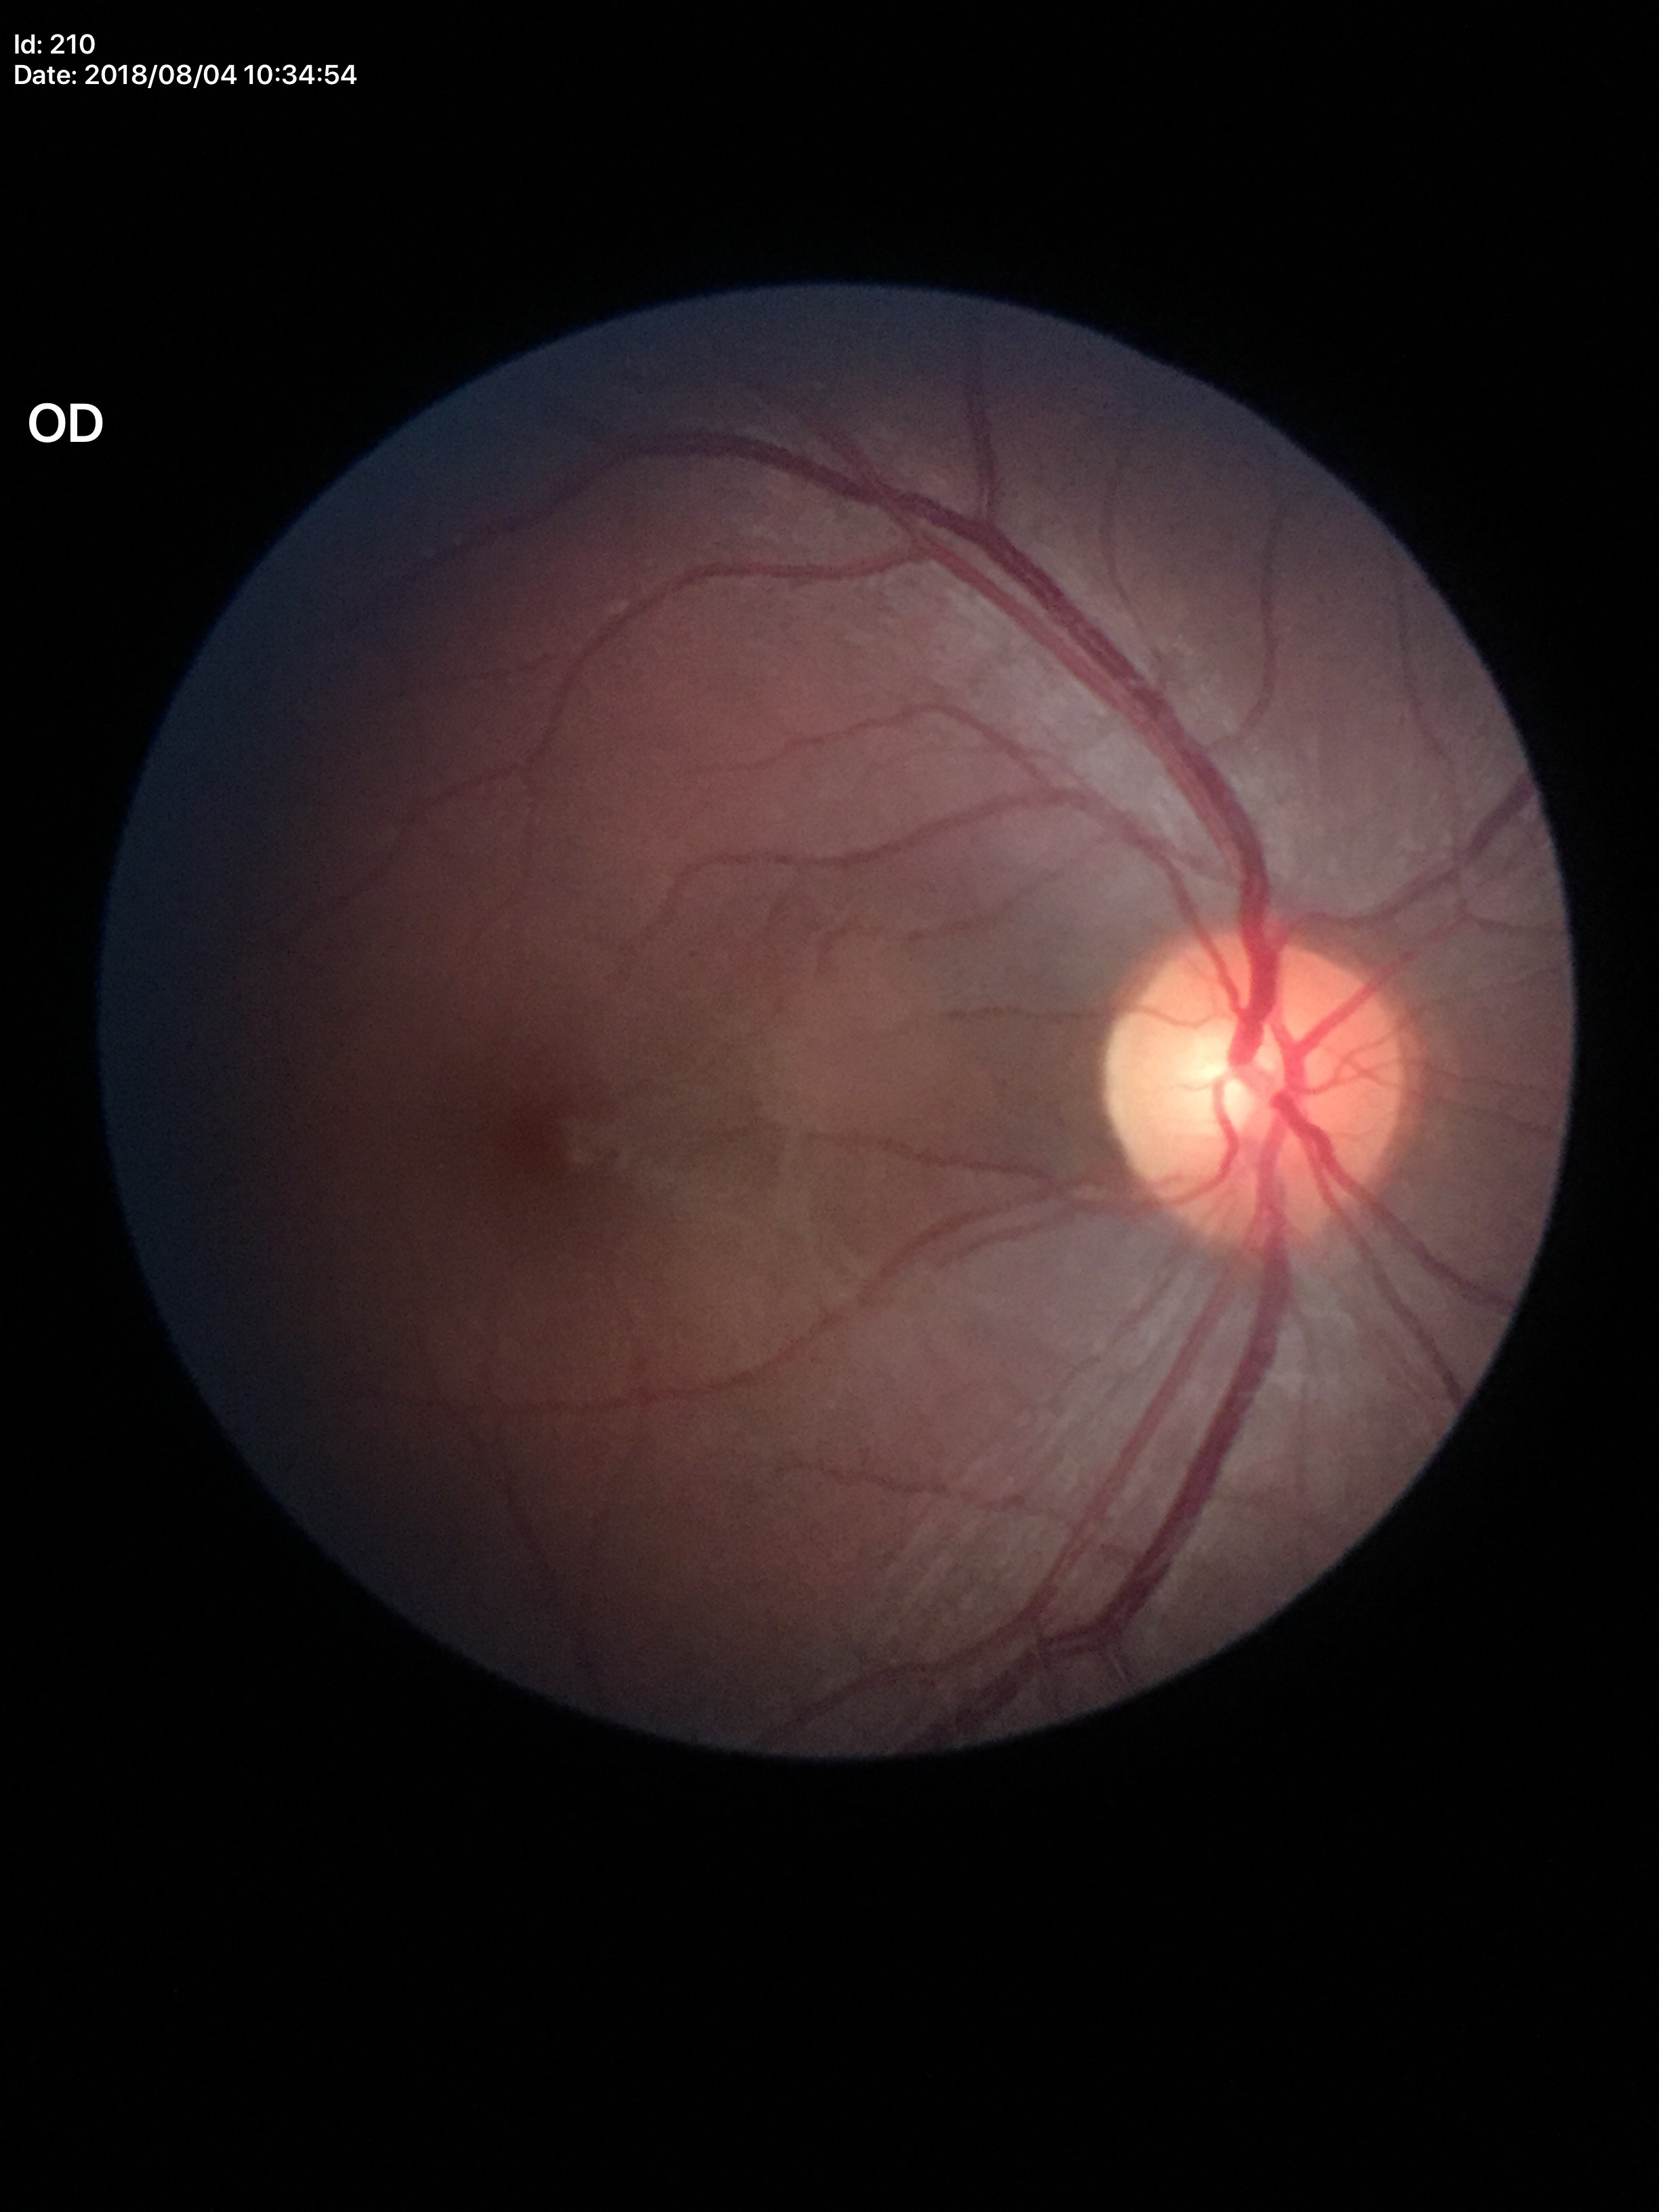

horizontal CDR=0.51
Glaucoma decision=no suspicious findings
vertical cup-to-disc ratio=0.48